1747 x 1312 pixels; retinal fundus photograph
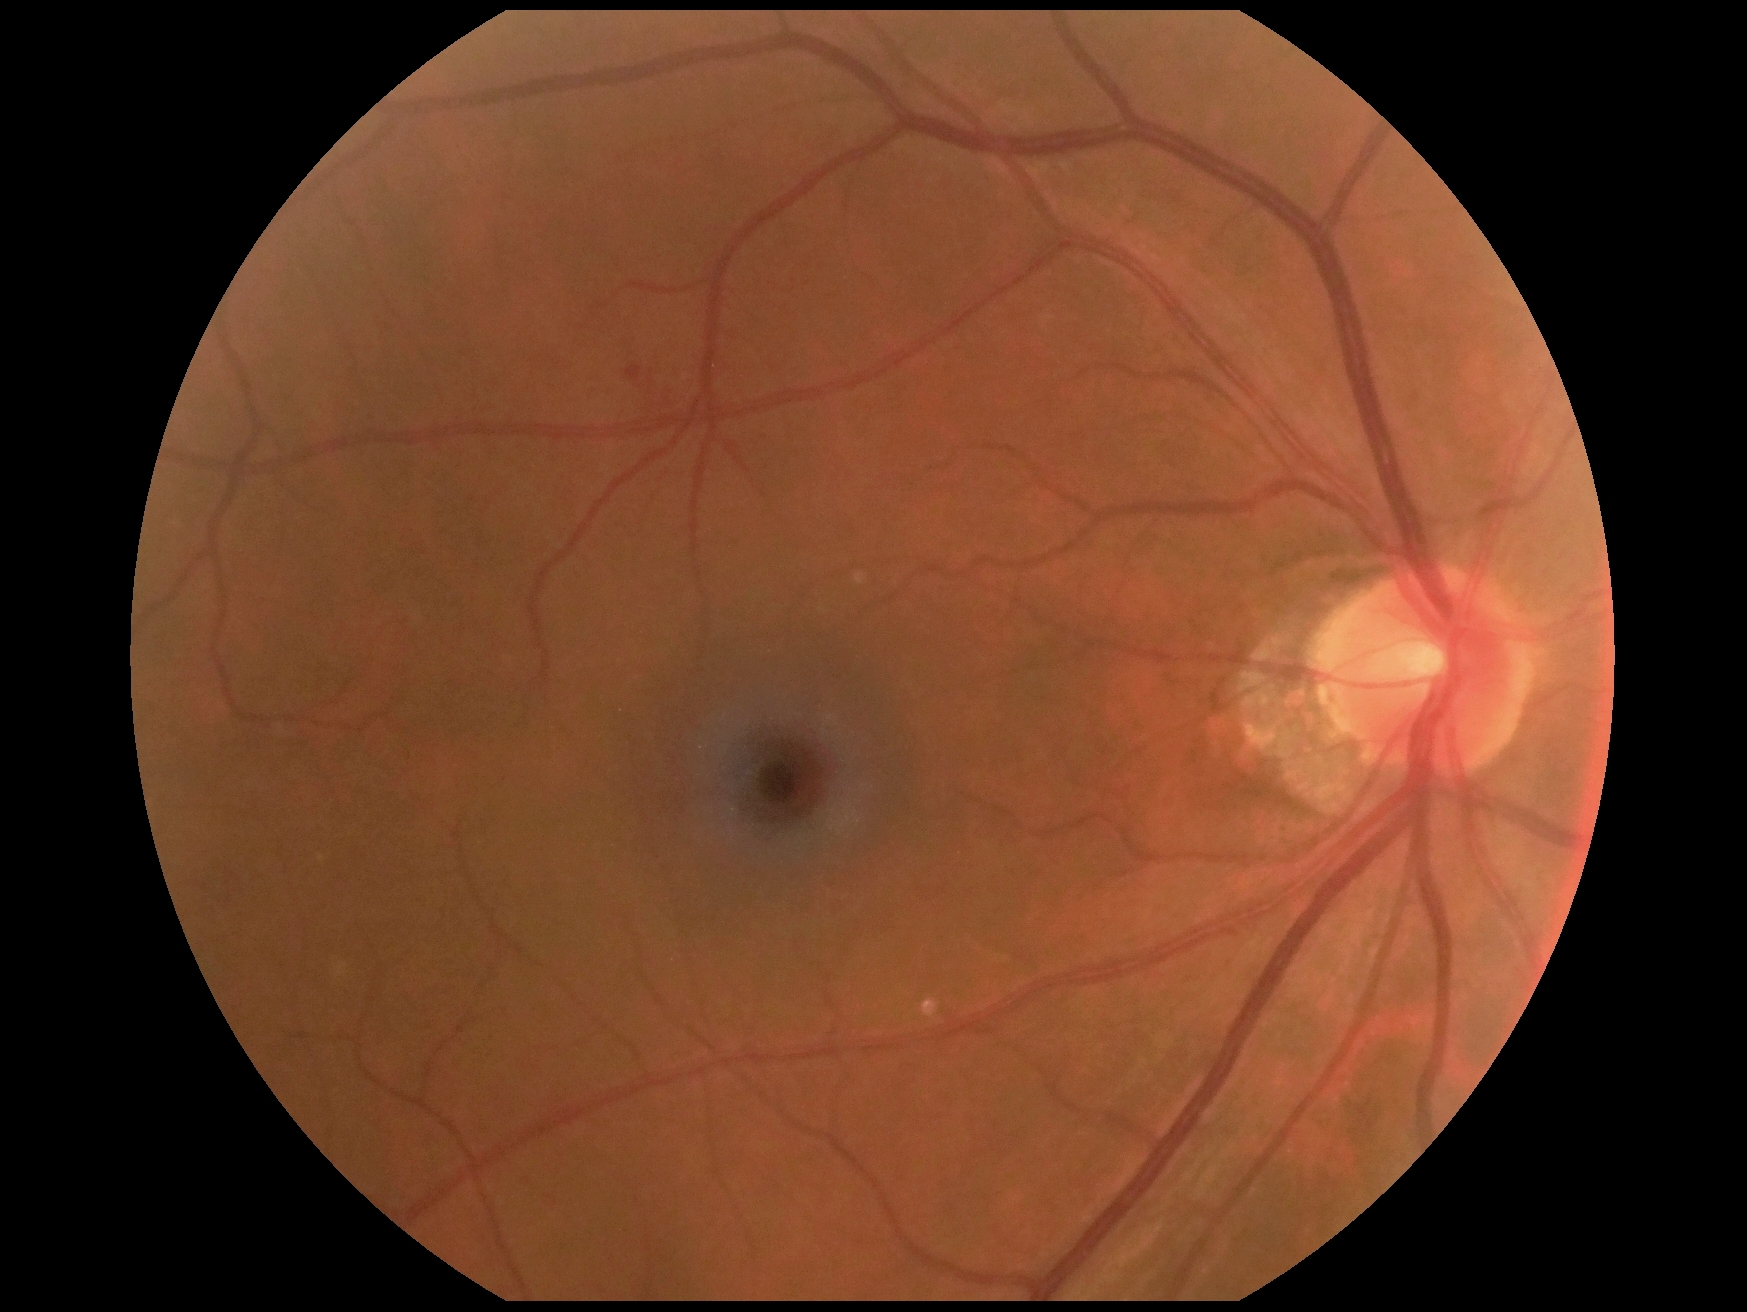 • DR grade — moderate NPDR (2)